FOV: 45 degrees:
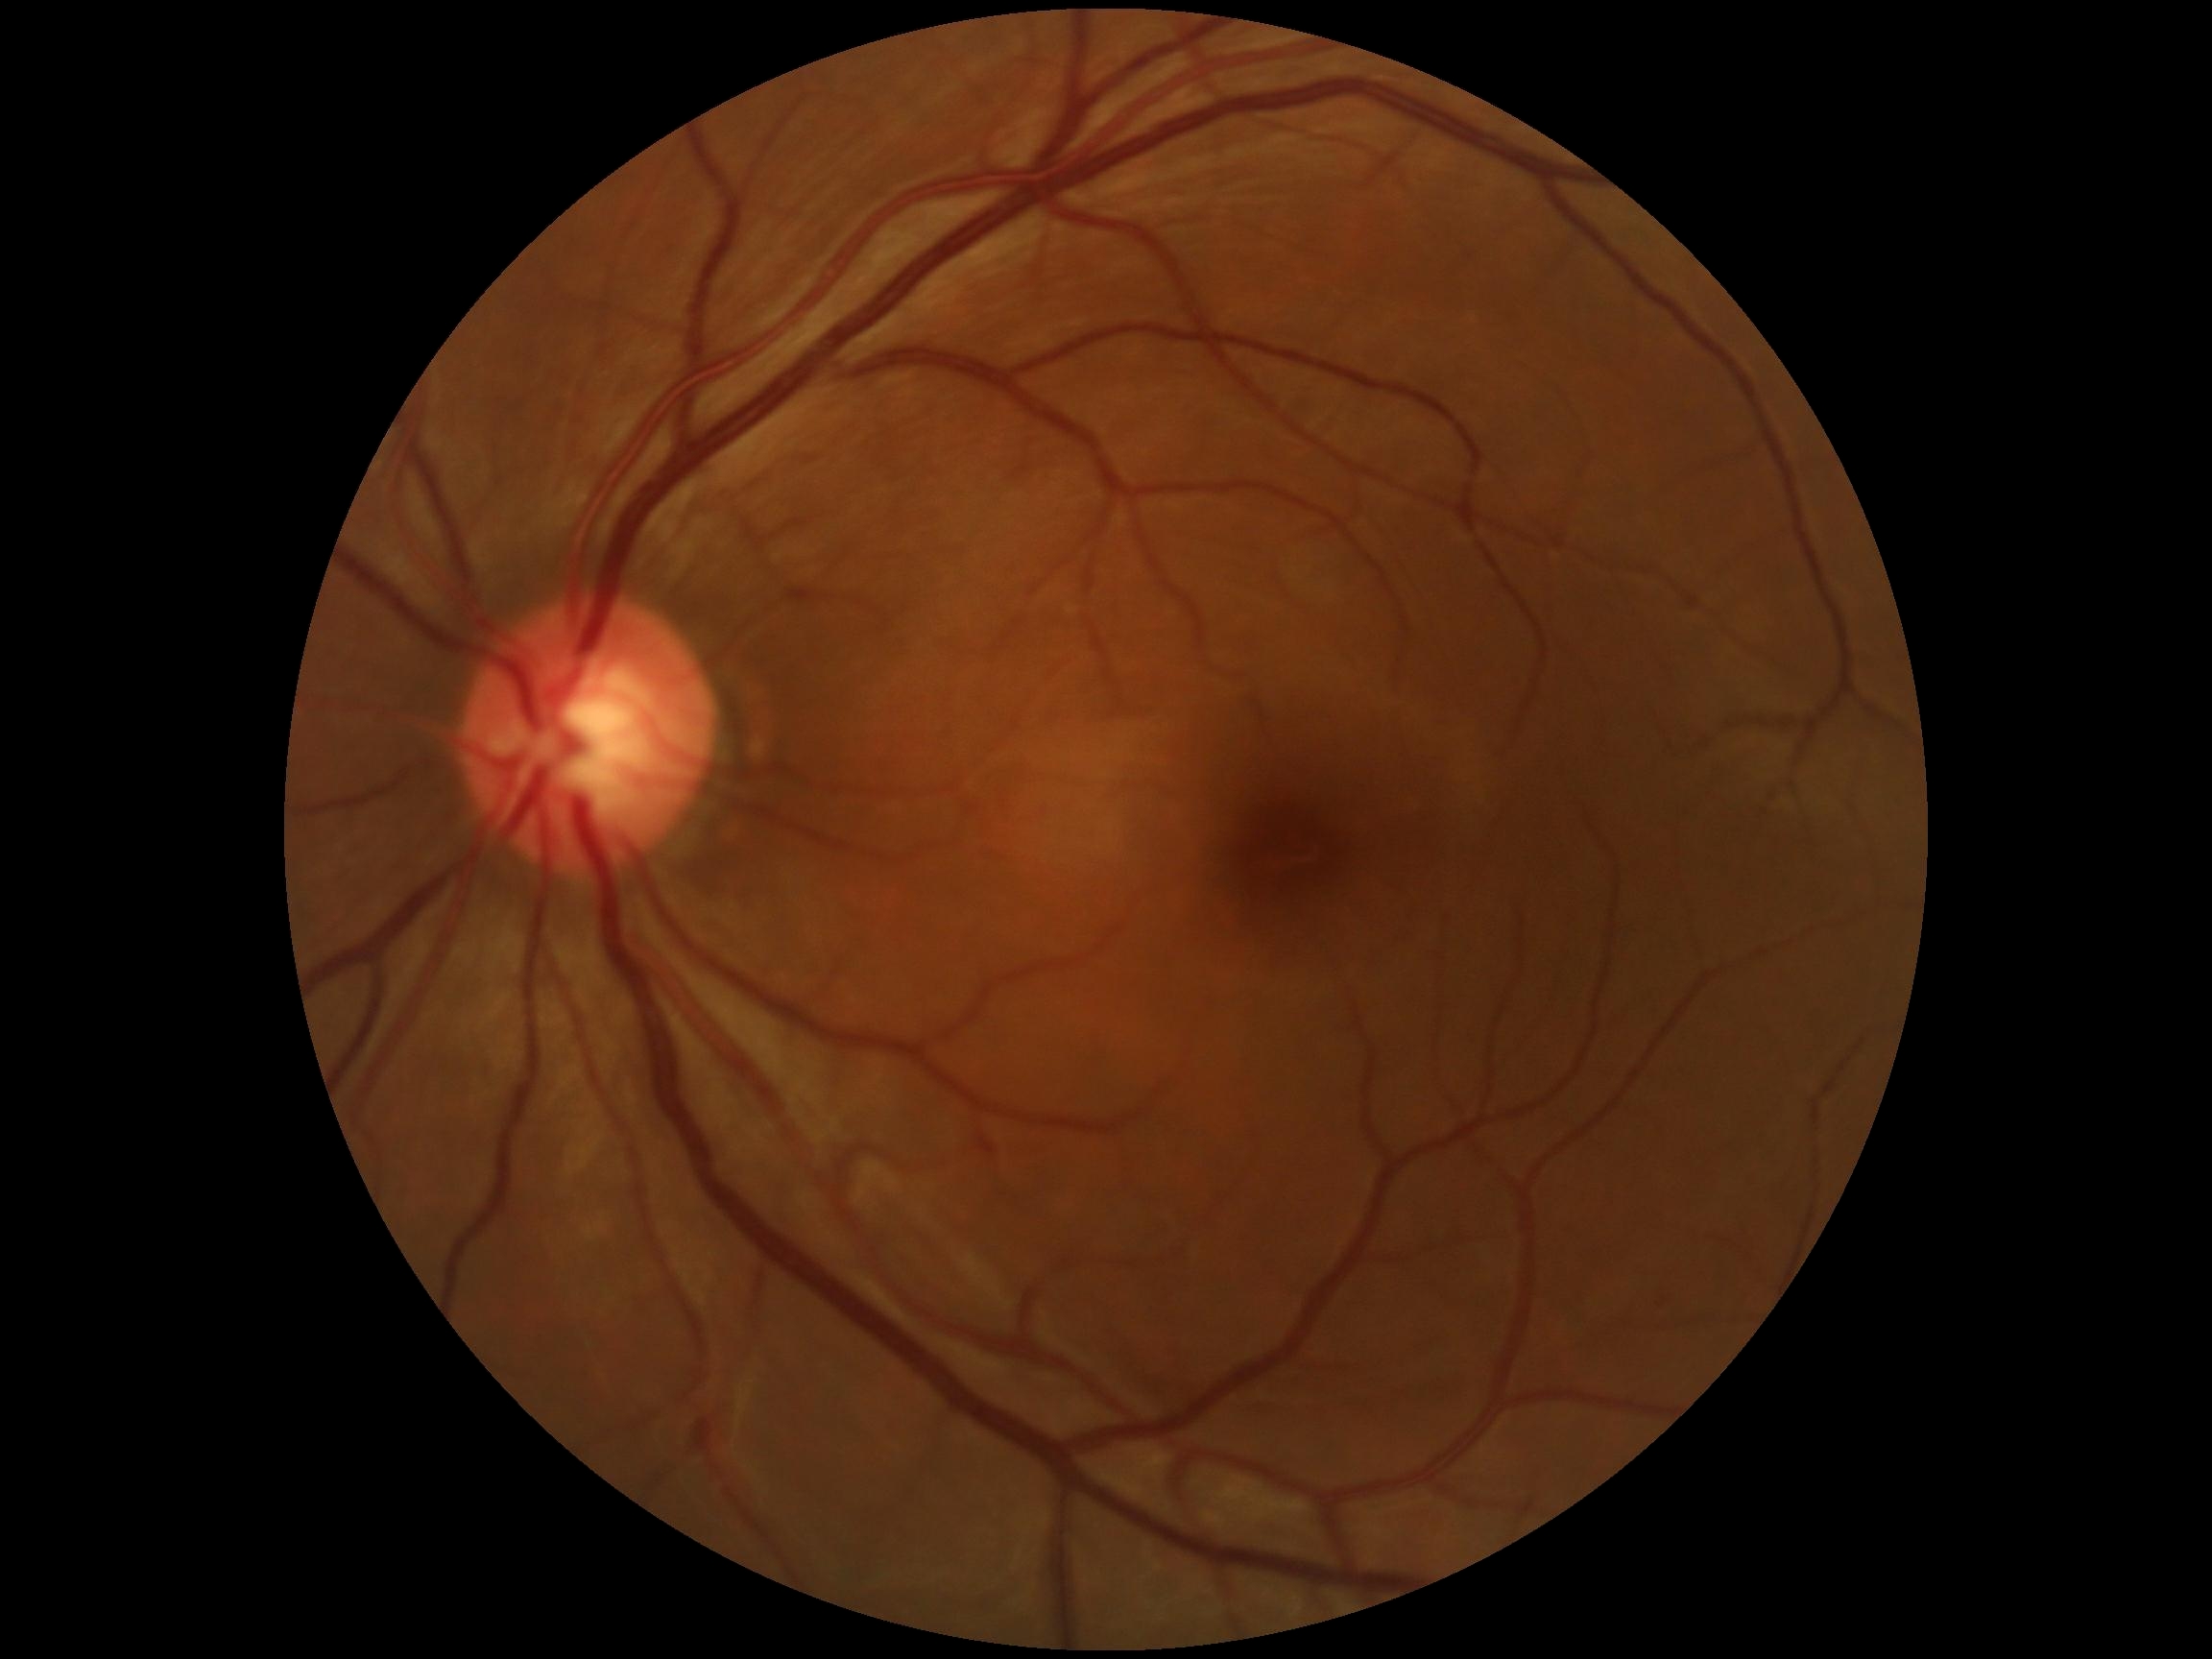
Diabetic retinopathy (DR): 0.